Dilated pupil · disc-centered fundus crop
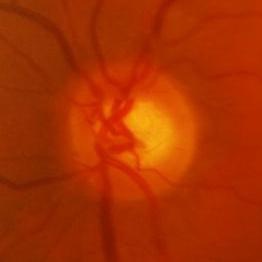 Finding: glaucomatous optic neuropathy.